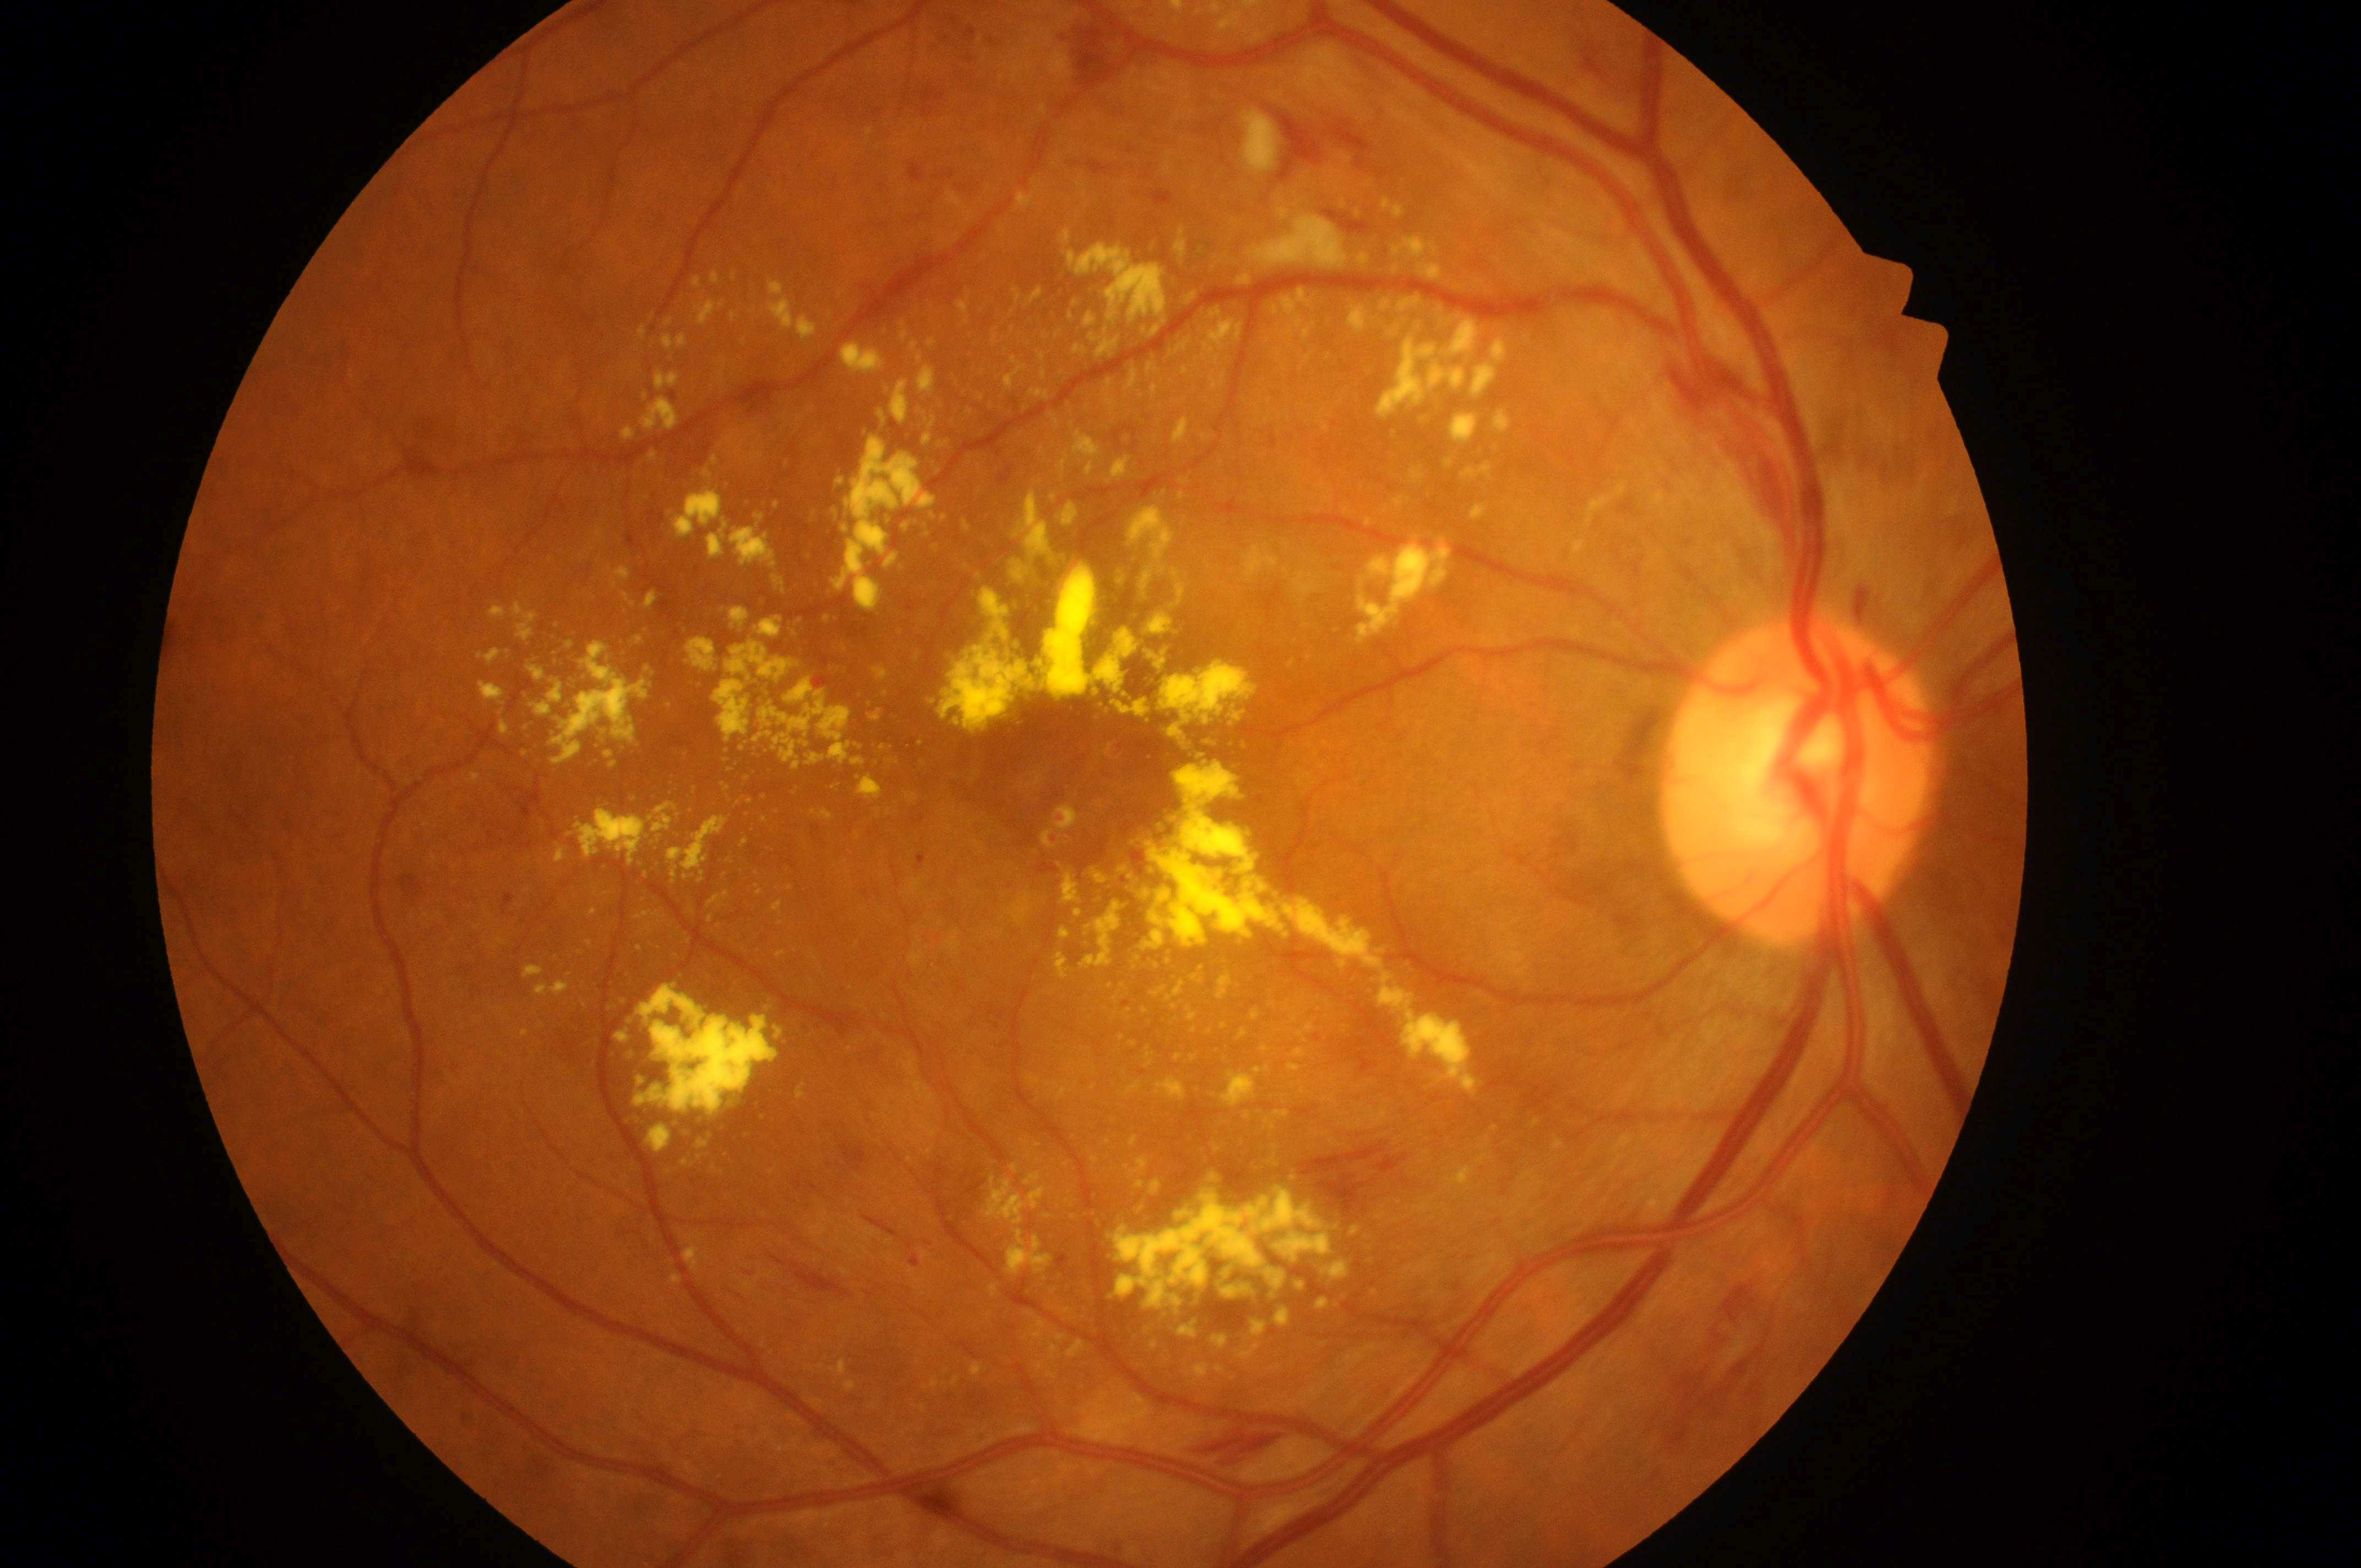 The image shows the OD. Diabetic retinopathy: severe non-proliferative diabetic retinopathy (grade 3). Macular edema risk is high risk (grade 2). Fovea located at (x=1082, y=790). Optic disc center: (x=1794, y=792).